DR severity per modified Davis staging · camera: NIDEK AFC-230 · posterior pole photograph: 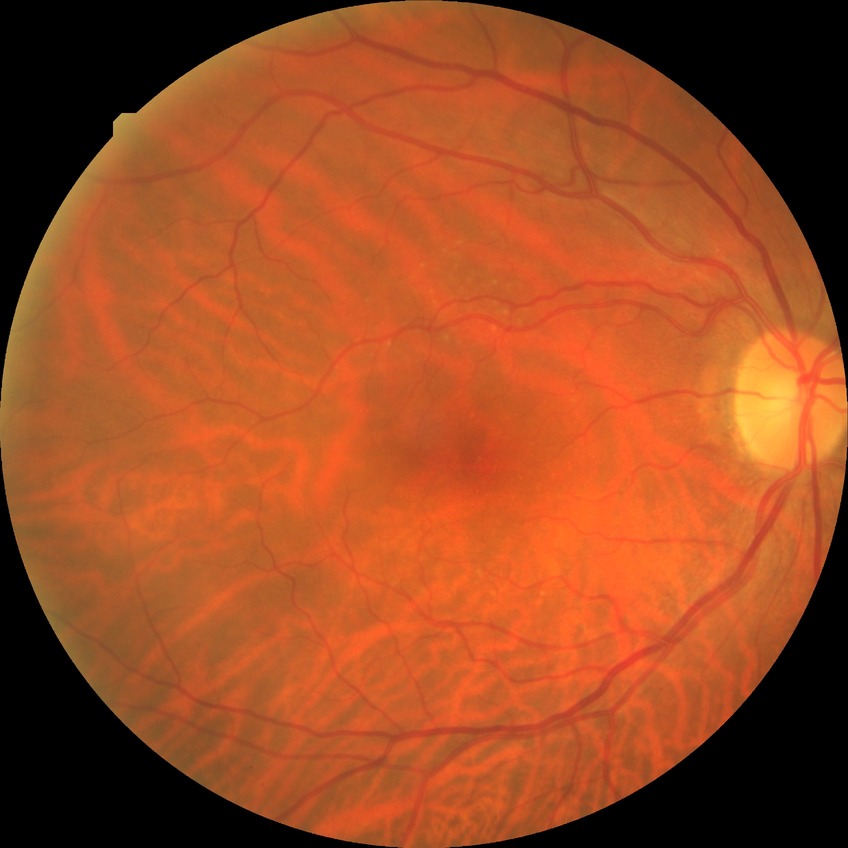 Diabetic retinopathy (DR) is NDR (no diabetic retinopathy).